Acquired with a NIDEK AFC-230 · posterior pole color fundus photograph:
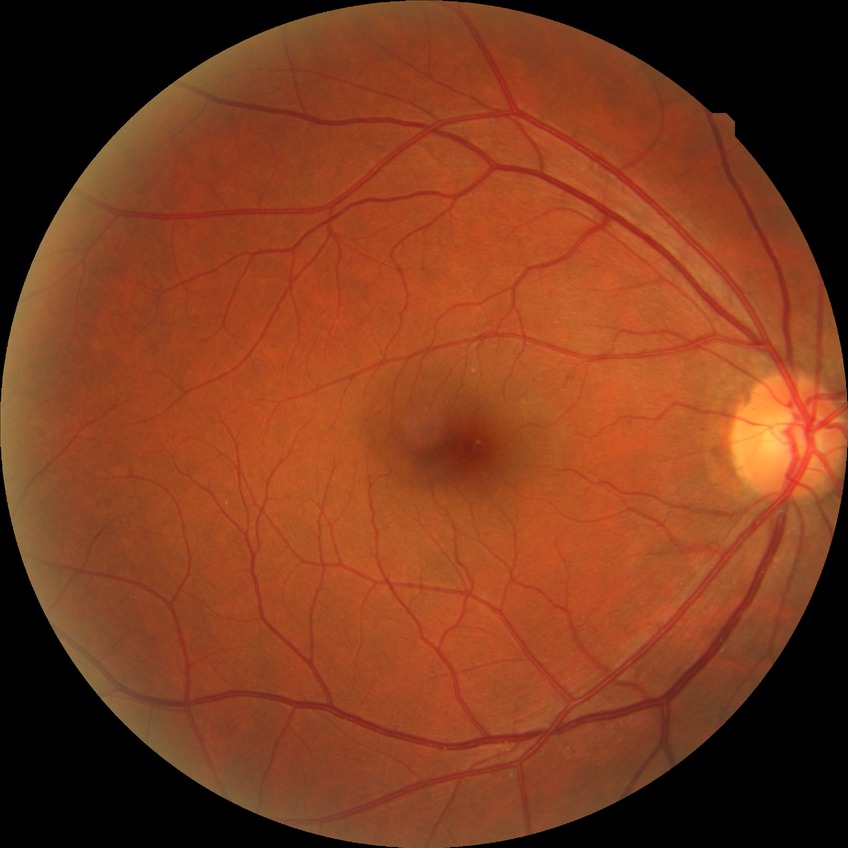
Diabetic retinopathy (DR) is NDR (no diabetic retinopathy).